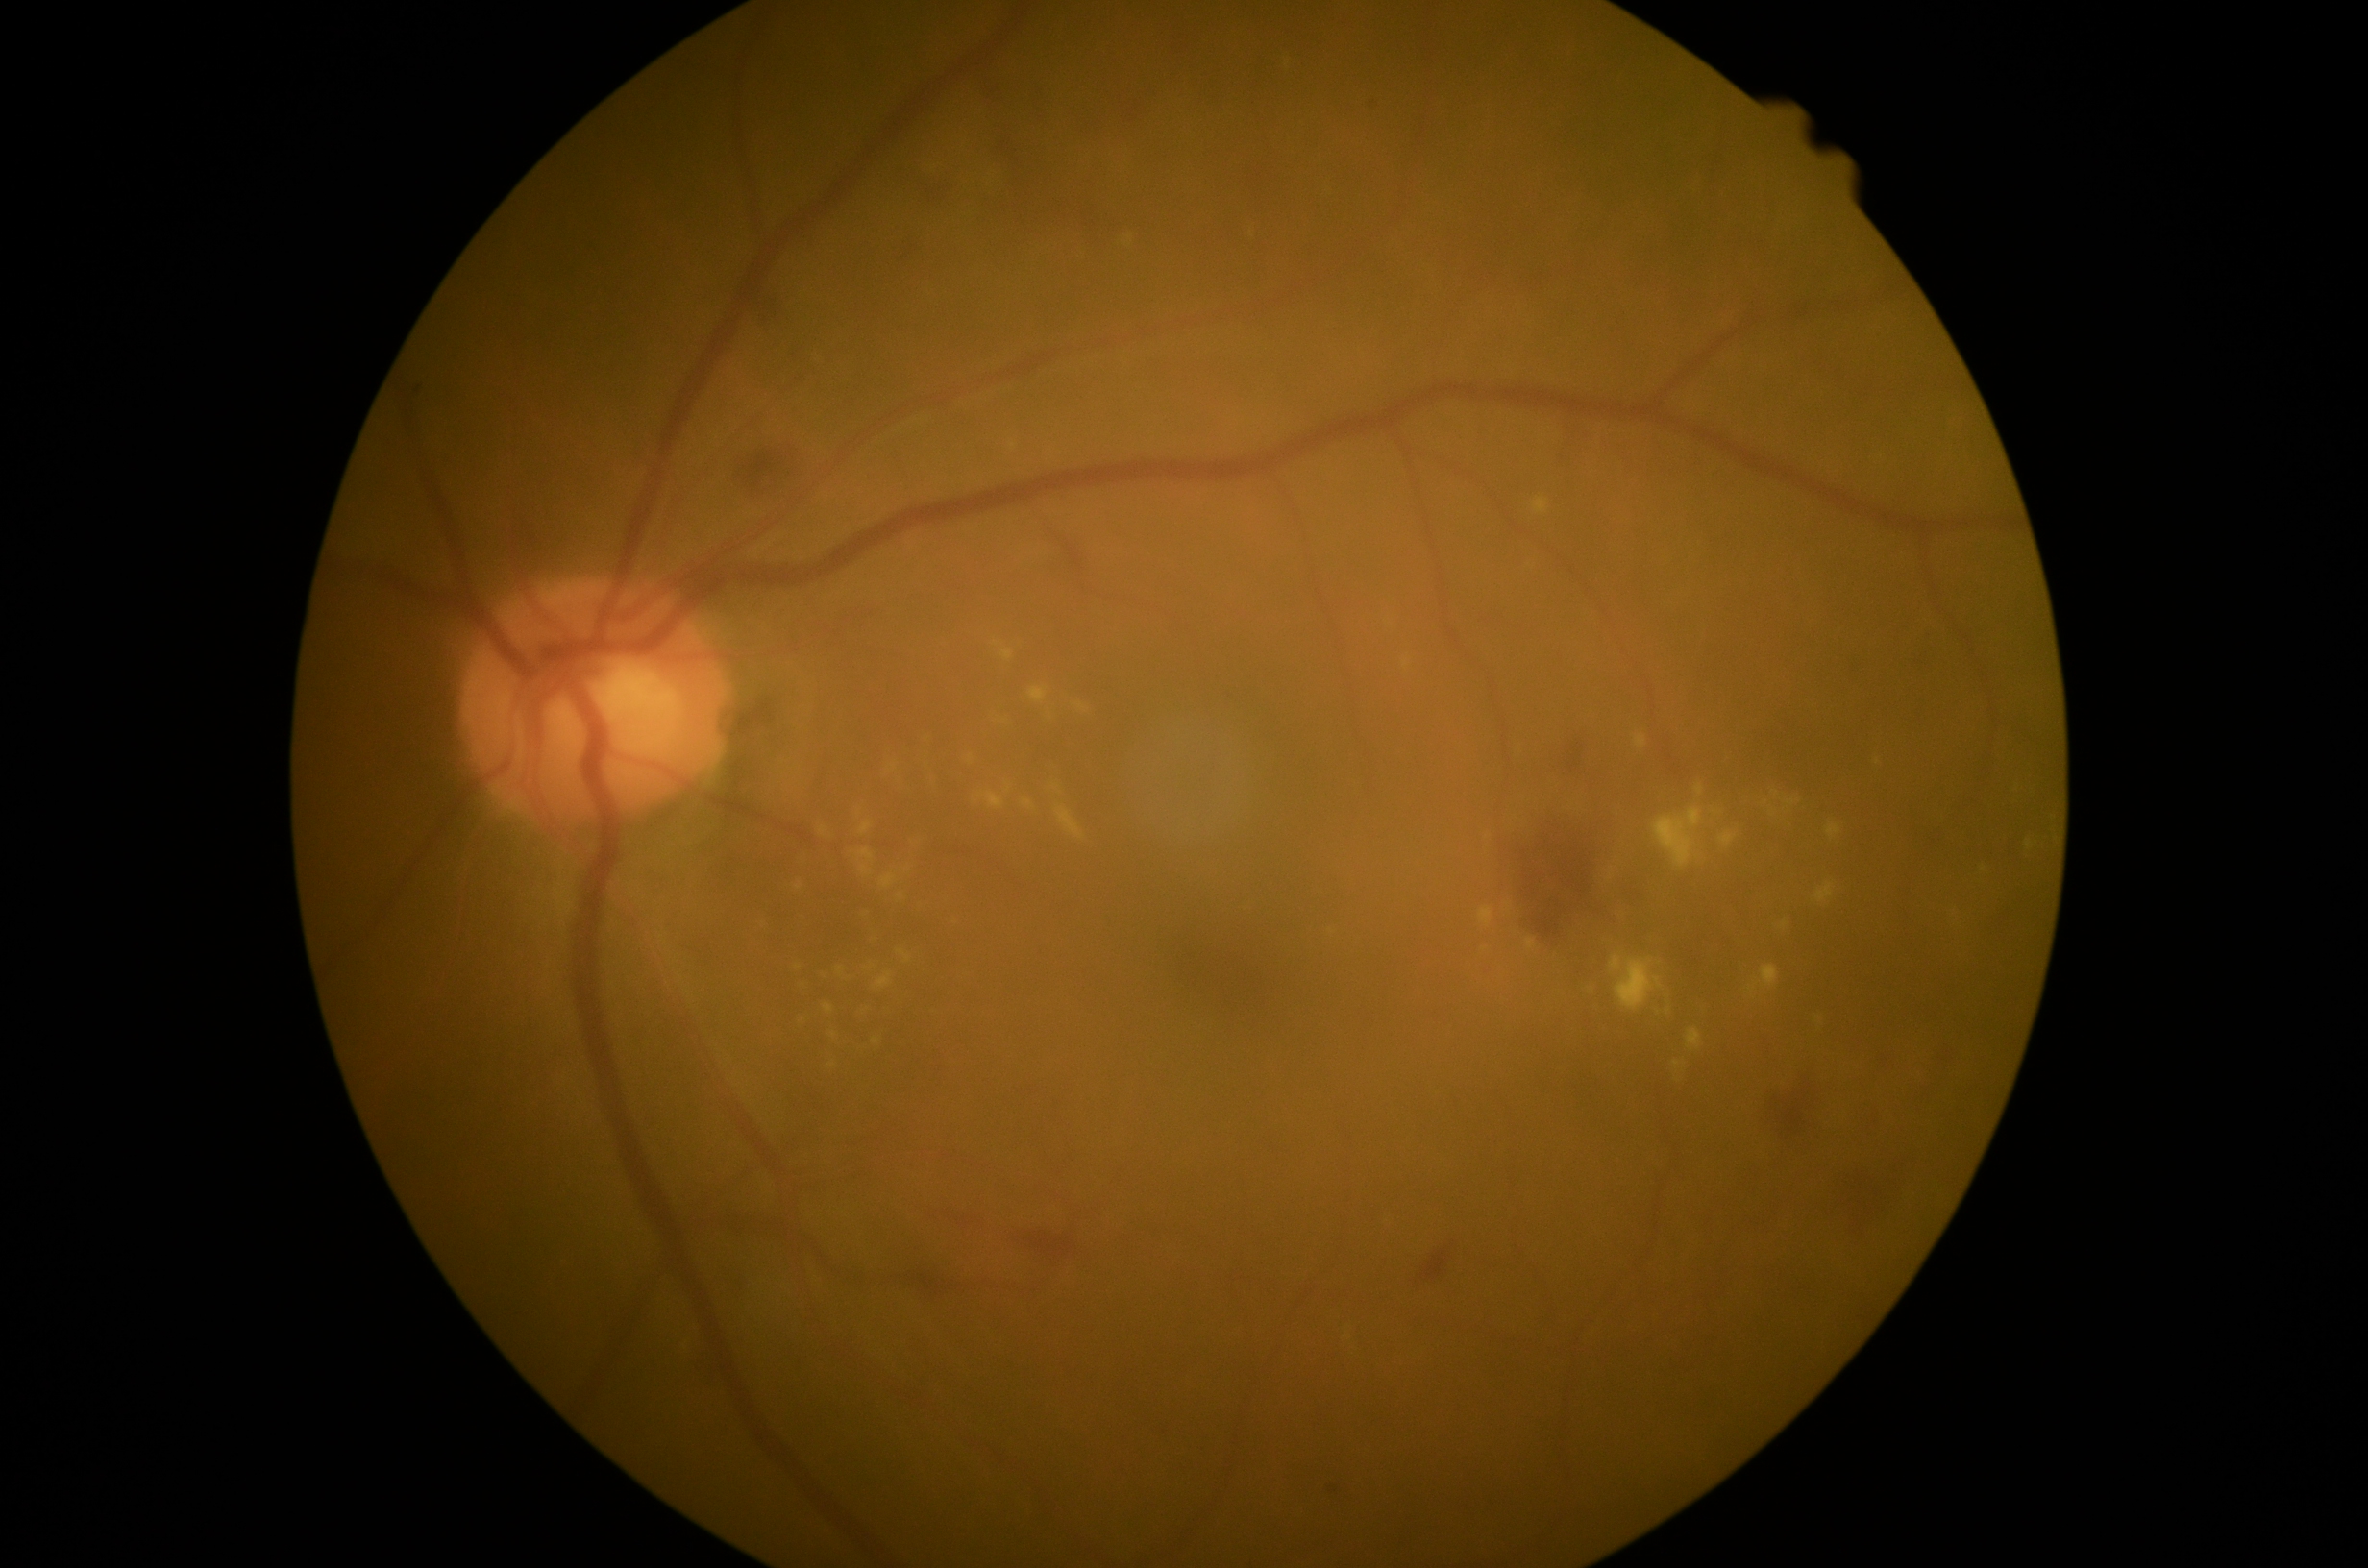 DR severity is grade 2 (moderate NPDR); non-proliferative diabetic retinopathy
Lesions identified (partial list):
- MAs: x1=1326 y1=1484 x2=1343 y2=1497; x1=1371 y1=102 x2=1380 y2=109
- SEs: not present
- EXs (more not shown): x1=2027 y1=840 x2=2034 y2=850; x1=1653 y1=809 x2=1704 y2=871; x1=1747 y1=965 x2=1780 y2=994; x1=880 y1=874 x2=898 y2=891; x1=1780 y1=919 x2=1790 y2=930; x1=837 y1=967 x2=846 y2=977; x1=1023 y1=800 x2=1036 y2=812; x1=1816 y1=883 x2=1836 y2=904; x1=1029 y1=687 x2=1048 y2=704; x1=1636 y1=734 x2=1648 y2=749
- Small EXs approximately at (x=1879, y=763); (x=1776, y=793); (x=1009, y=792); (x=894, y=768); (x=1485, y=950); (x=877, y=1041); (x=834, y=1036)
- HEs (more not shown): x1=1560 y1=738 x2=1587 y2=774; x1=1412 y1=1241 x2=1461 y2=1289; x1=1519 y1=833 x2=1594 y2=947; x1=1767 y1=1076 x2=1820 y2=1140; x1=694 y1=1360 x2=720 y2=1387; x1=1685 y1=947 x2=1704 y2=968; x1=1016 y1=1227 x2=1081 y2=1269; x1=1594 y1=908 x2=1605 y2=917; x1=1126 y1=102 x2=1141 y2=125; x1=925 y1=184 x2=951 y2=205
- Small HEs approximately at (x=1029, y=195); (x=1016, y=206); (x=1088, y=126); (x=1062, y=207)